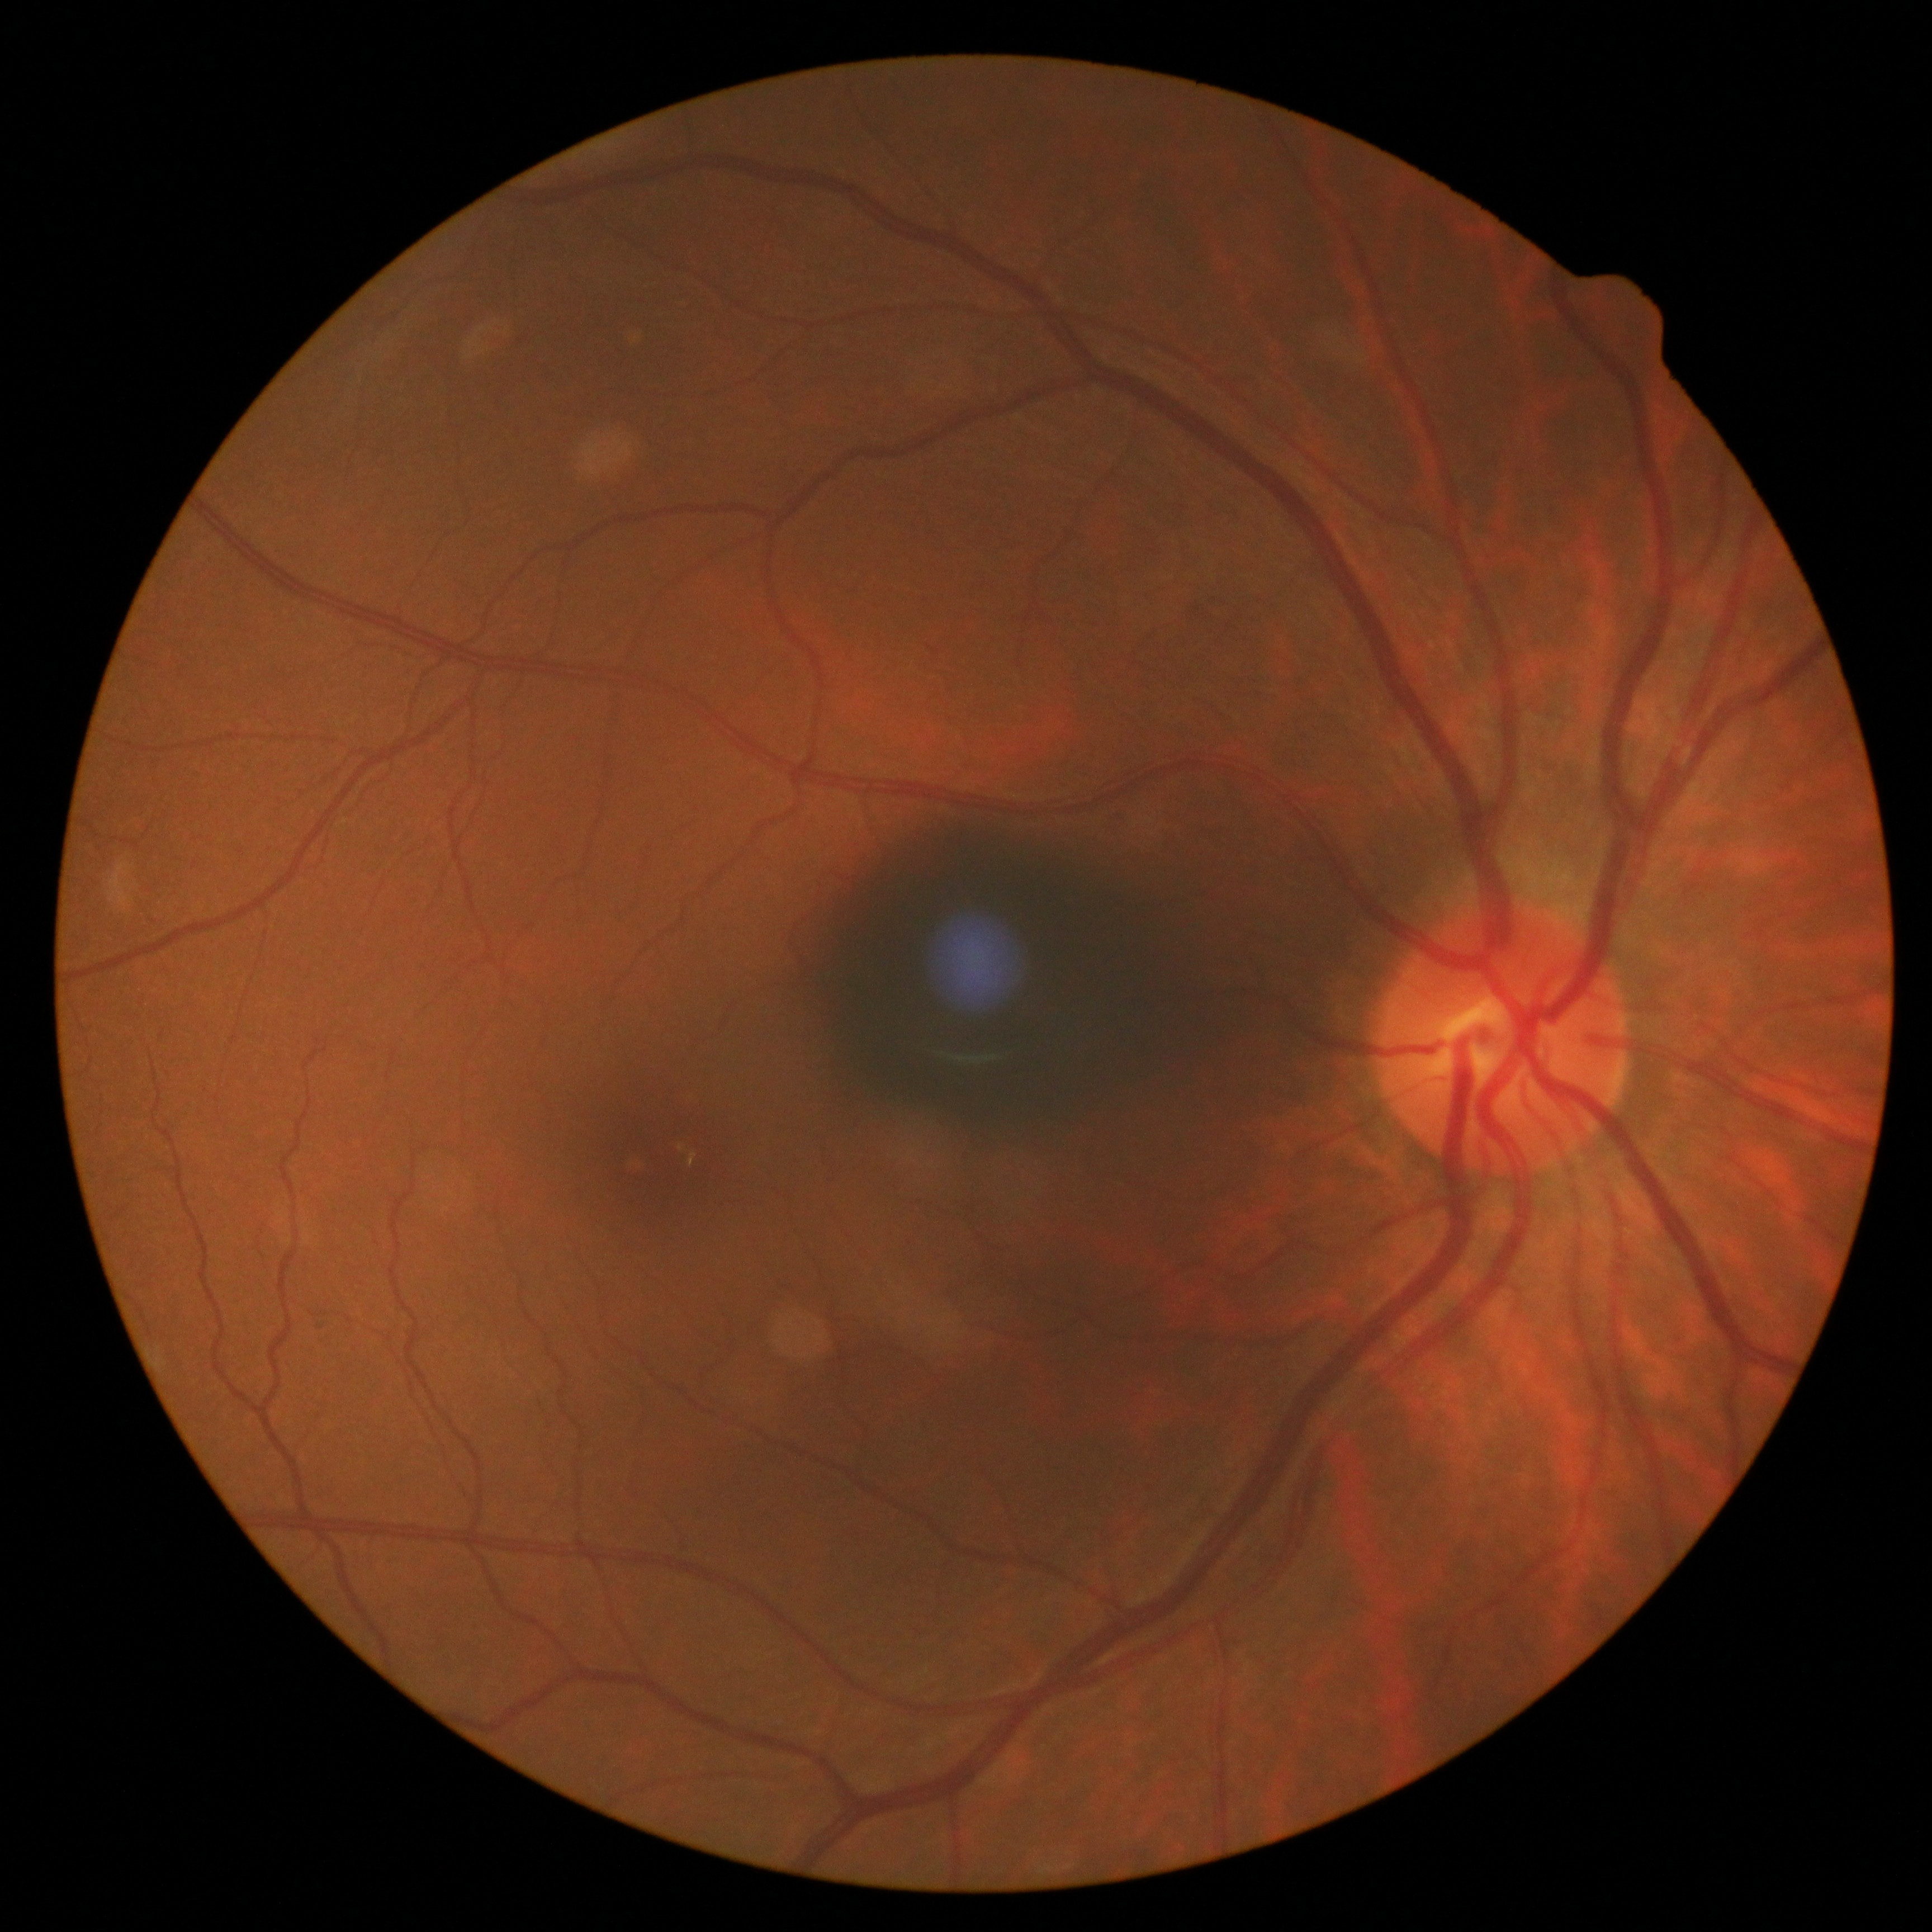
Diabetic retinopathy is no apparent retinopathy (grade 0) — no visible signs of diabetic retinopathy.